Image size 2212x1659 · FOV: 60 degrees:
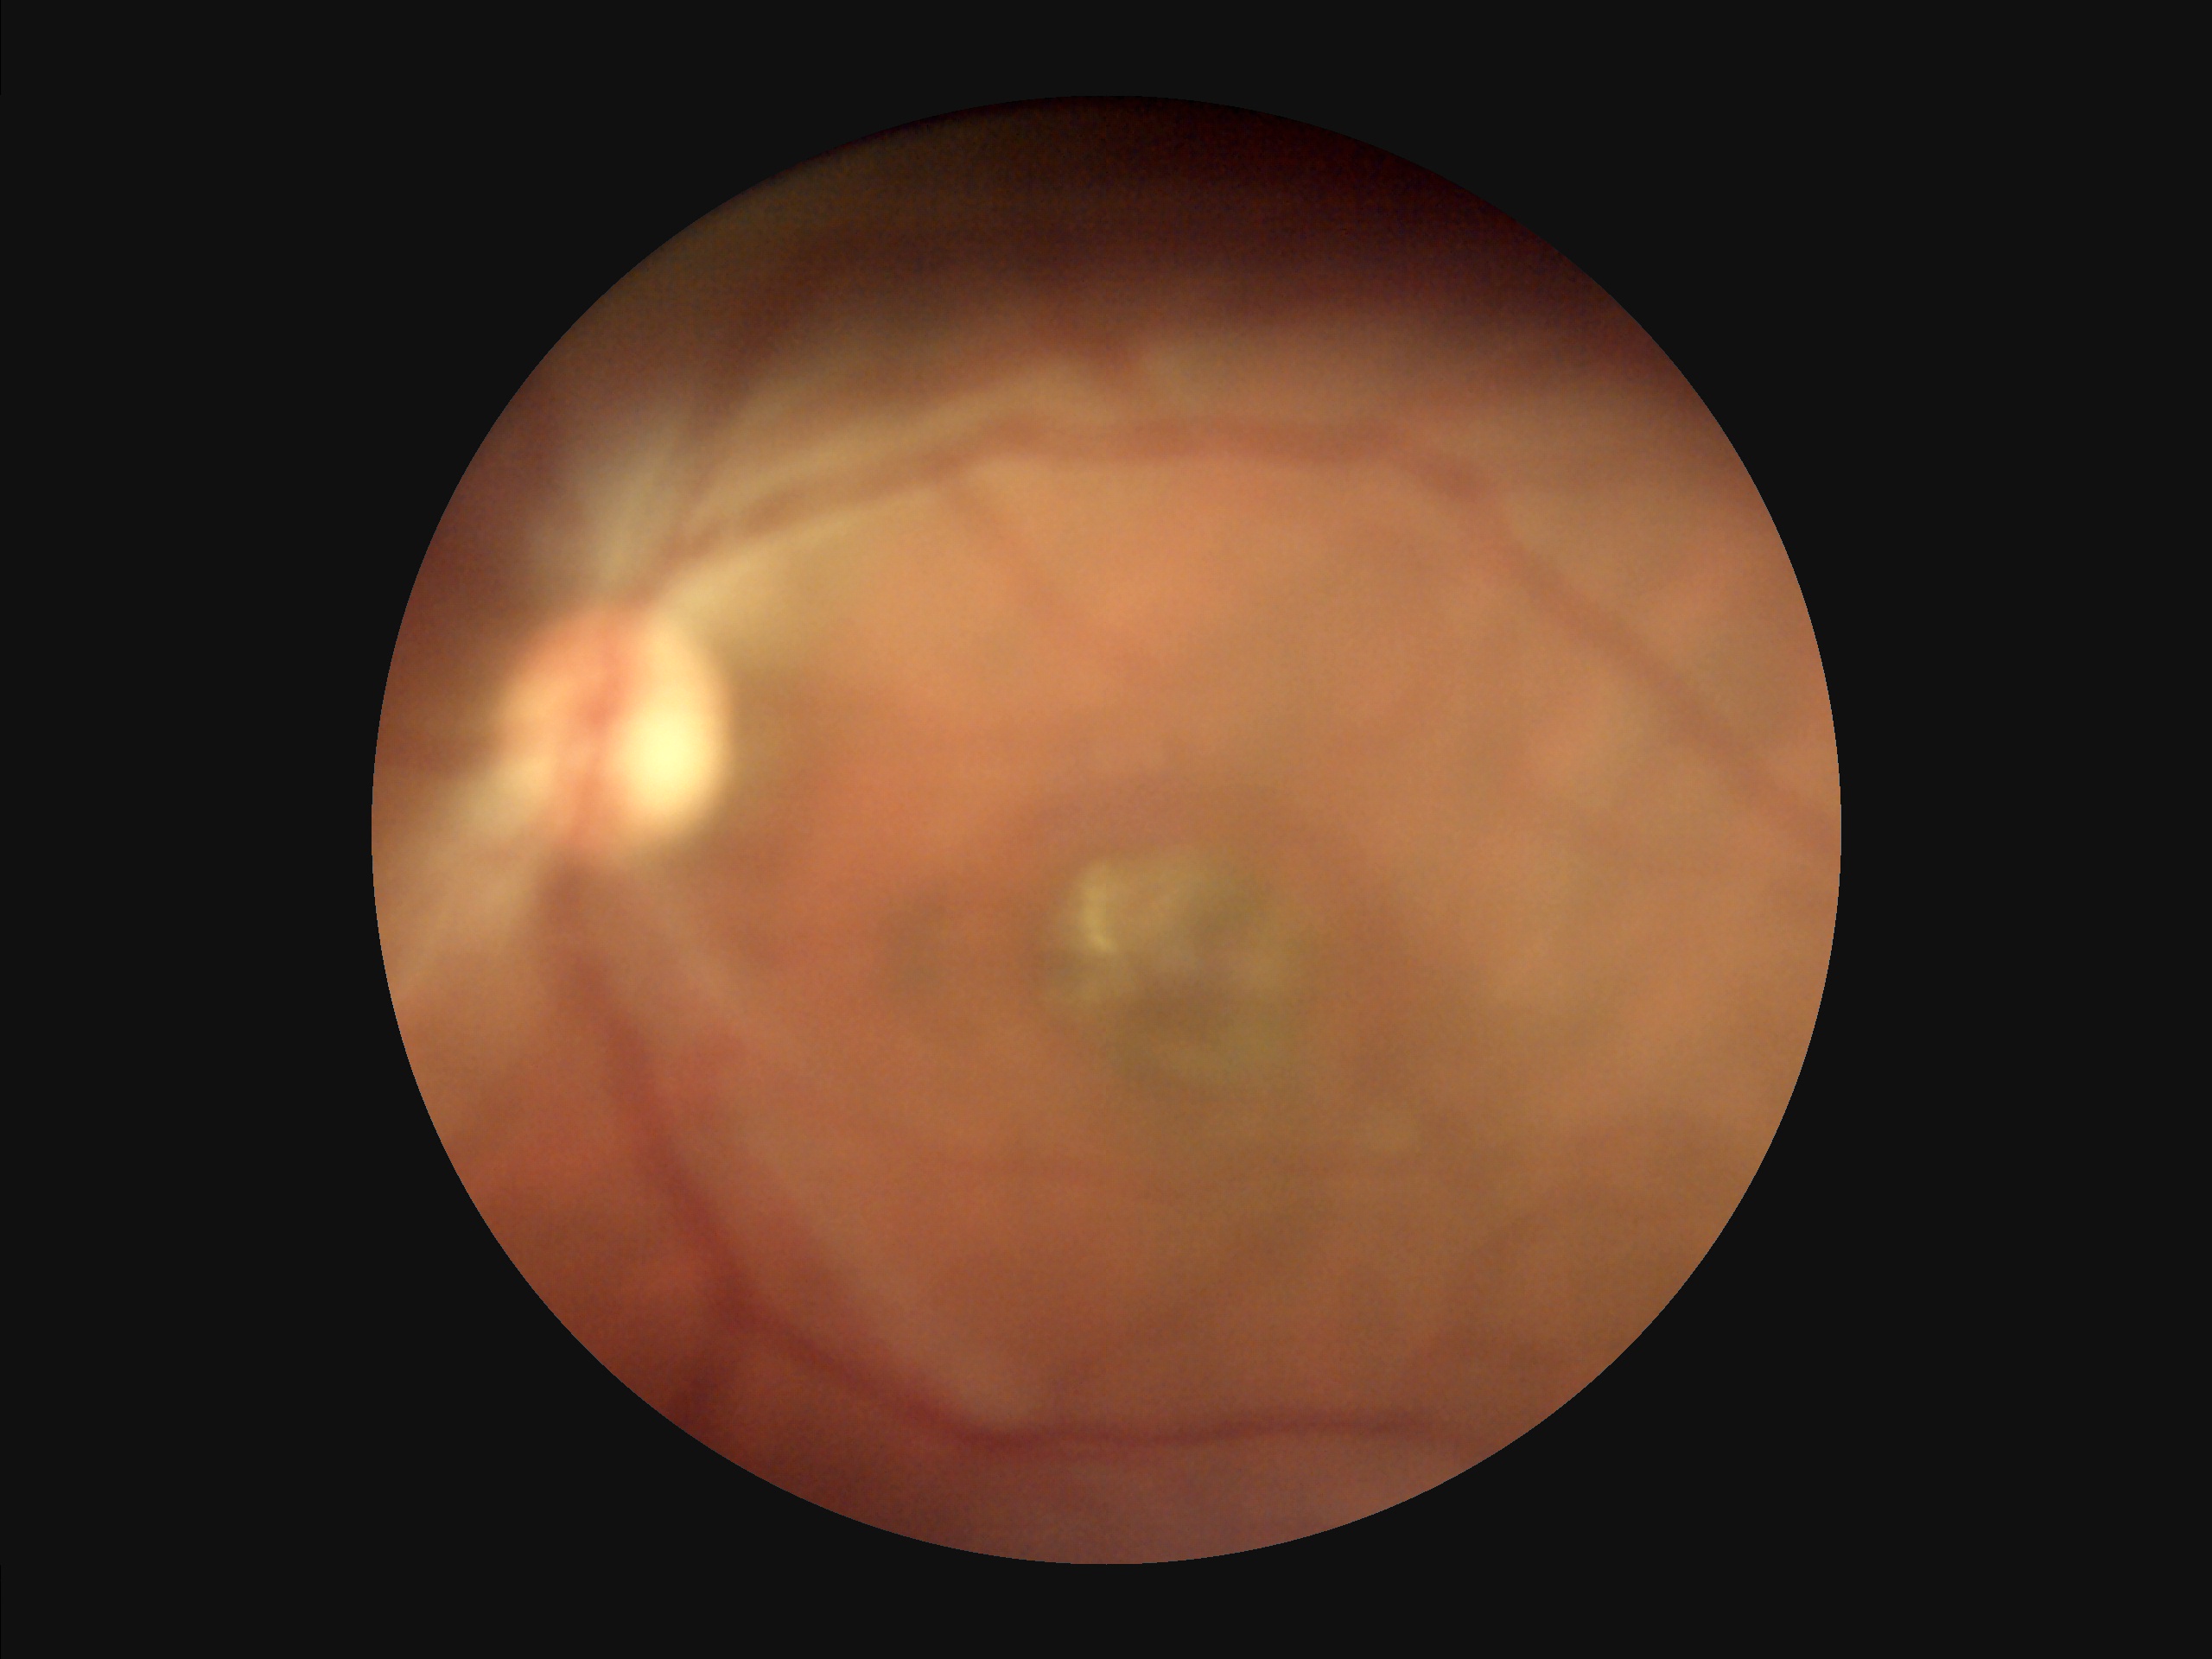 Illumination is uneven. Reduced sharpness with visible blur. Vessels and details are readily distinguishable. Image quality is inadequate for diagnostic use.